Infant wide-field retinal image
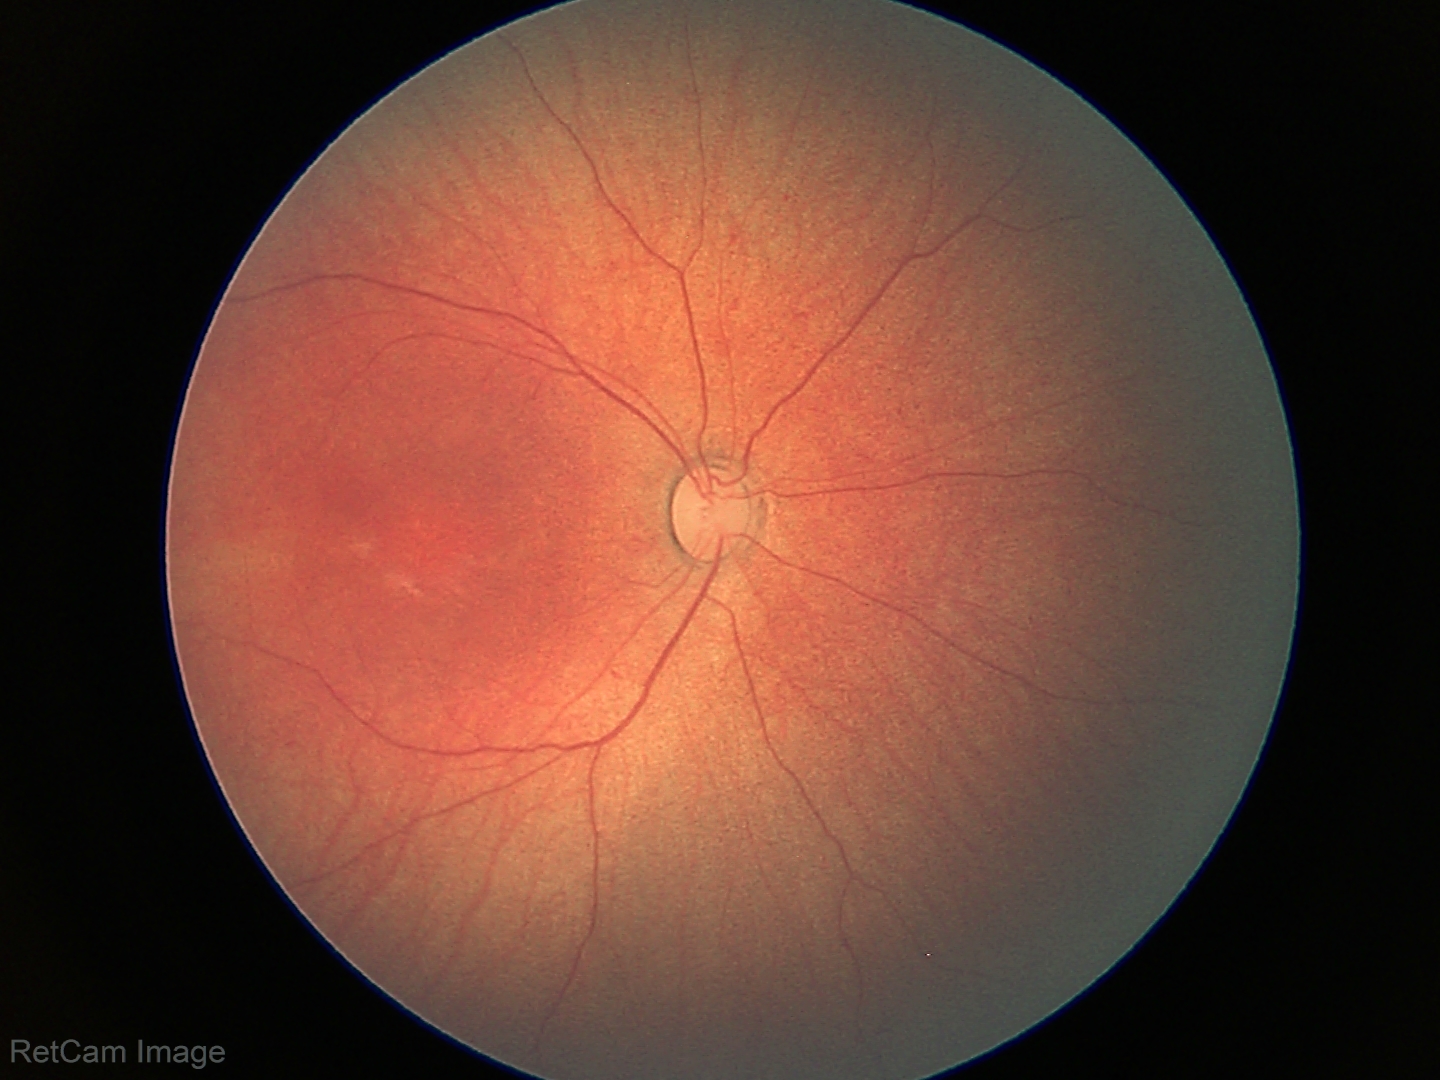
Examination with physiological retinal findings.